45° field of view. Retinal fundus photograph — 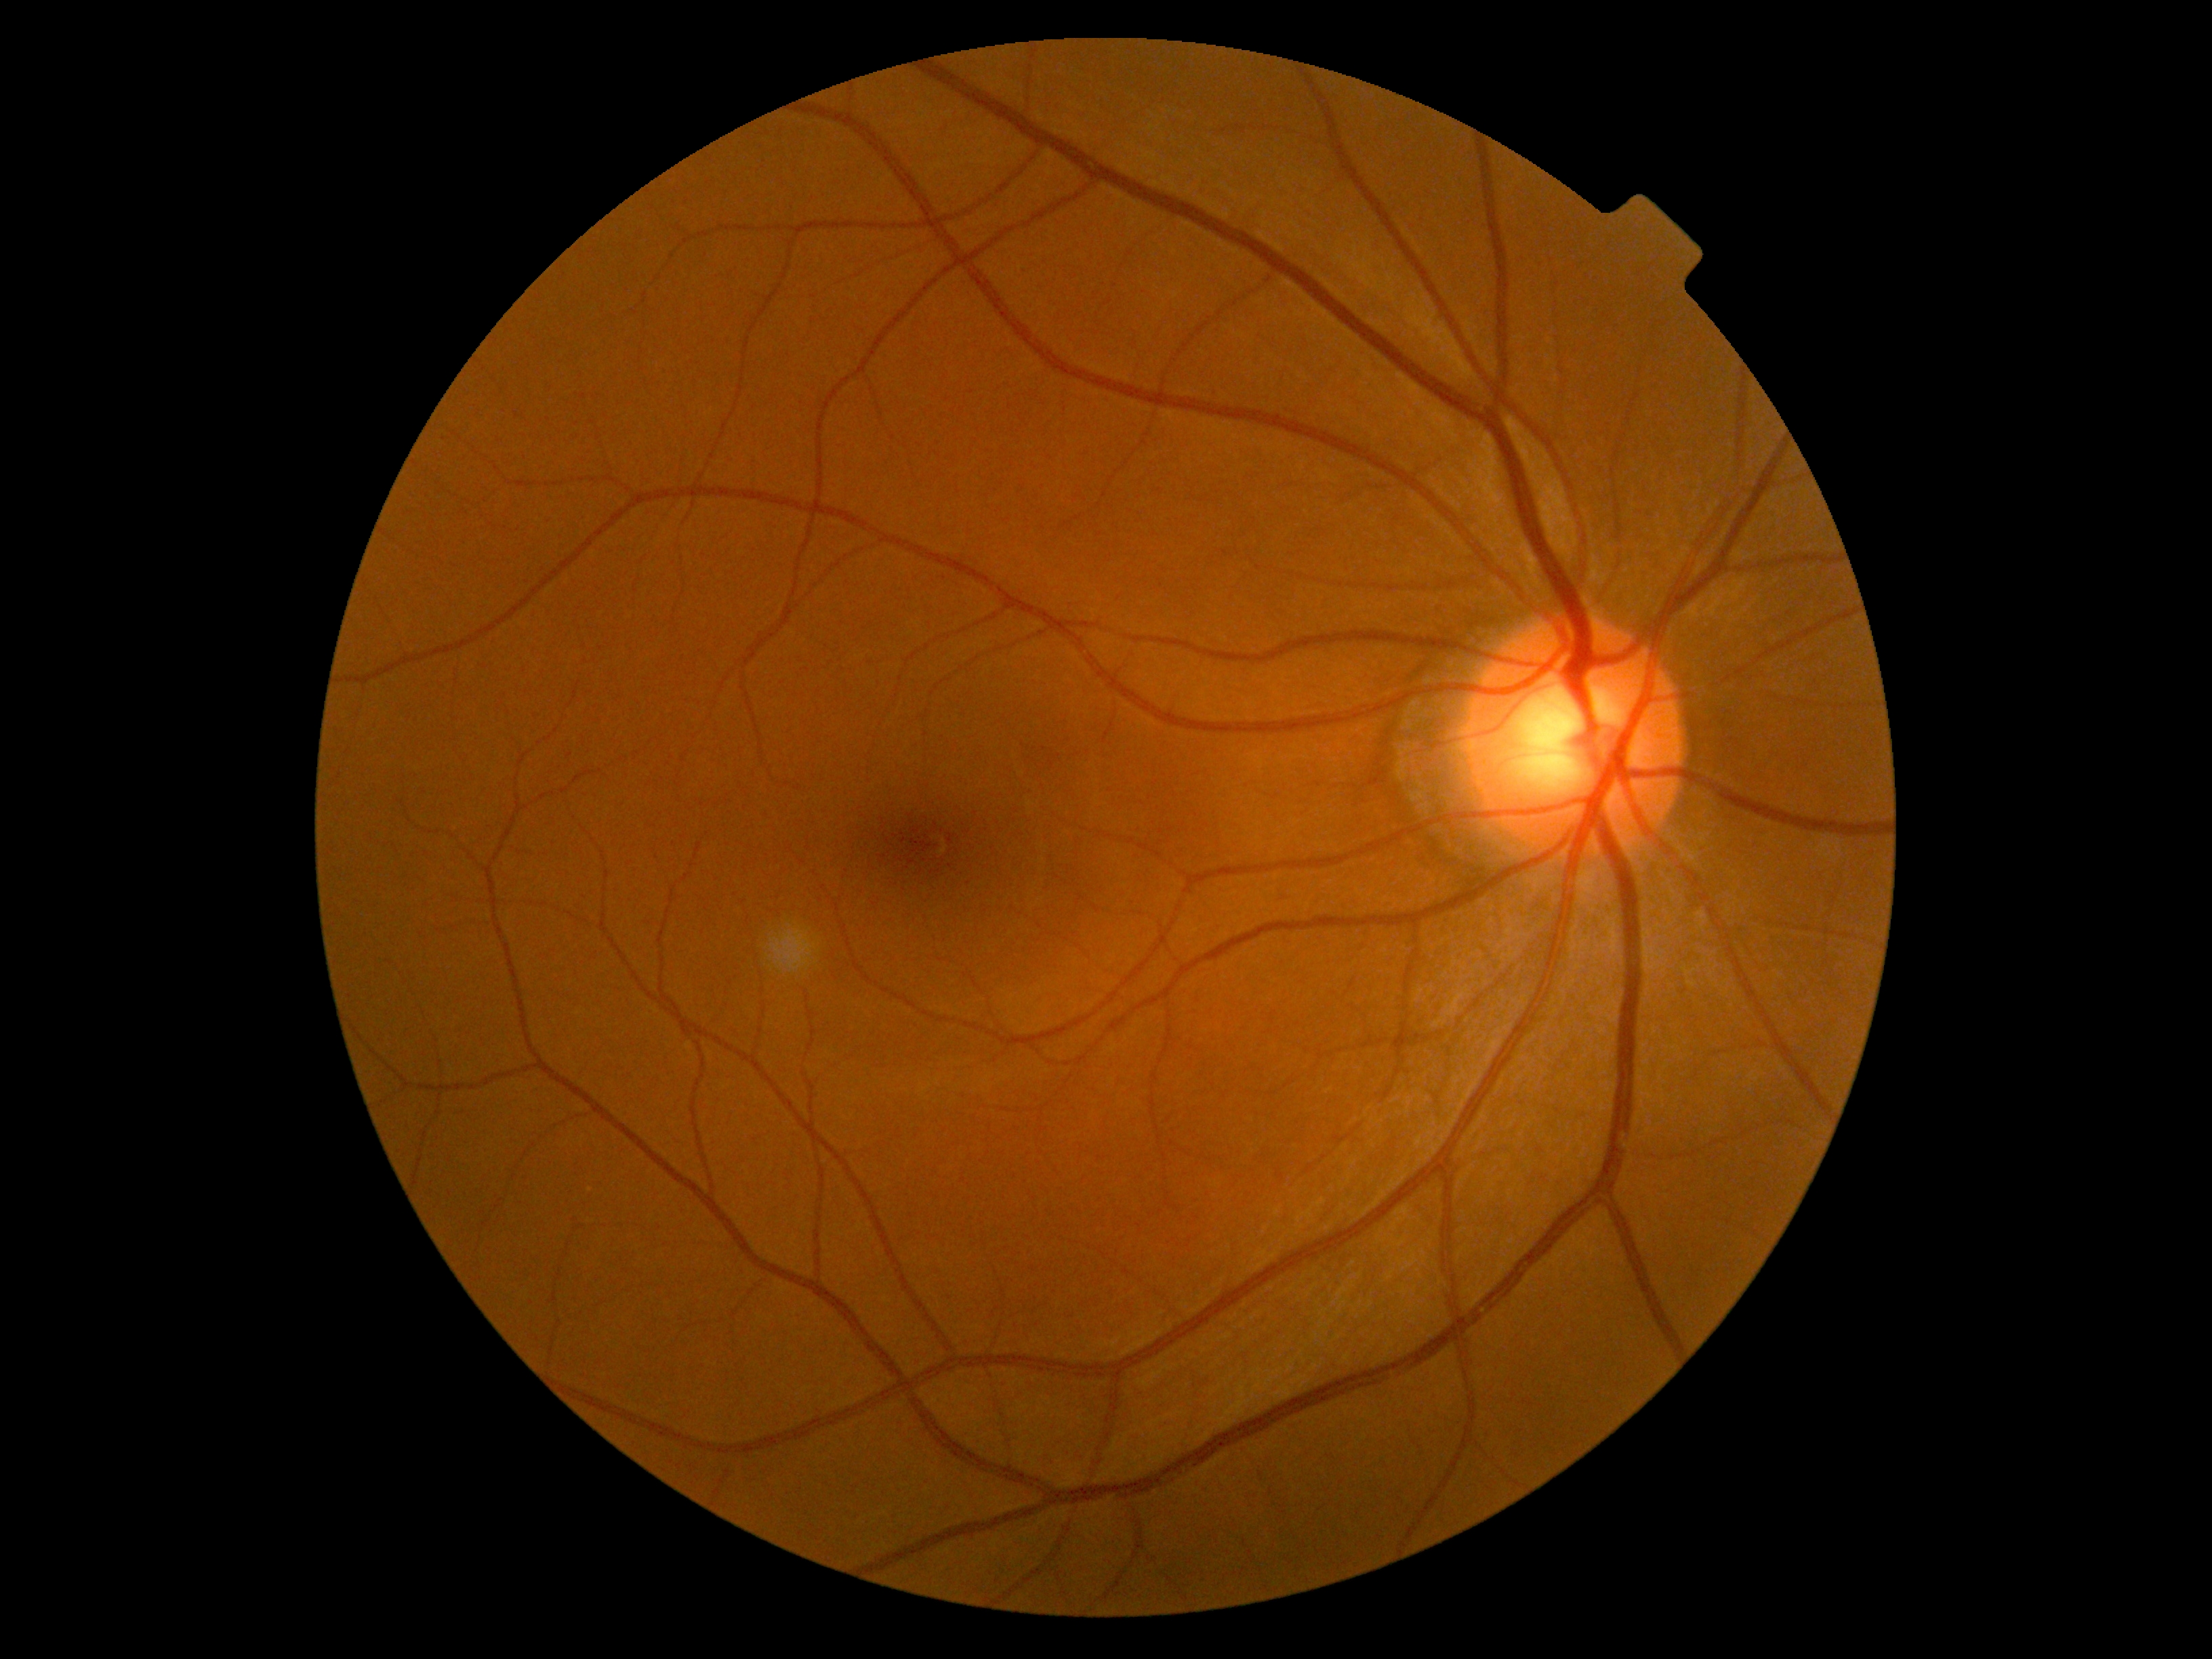 {"dr_impression": "no DR findings", "dr_grade": "0 (no apparent retinopathy)"}